Graded on the modified Davis scale — 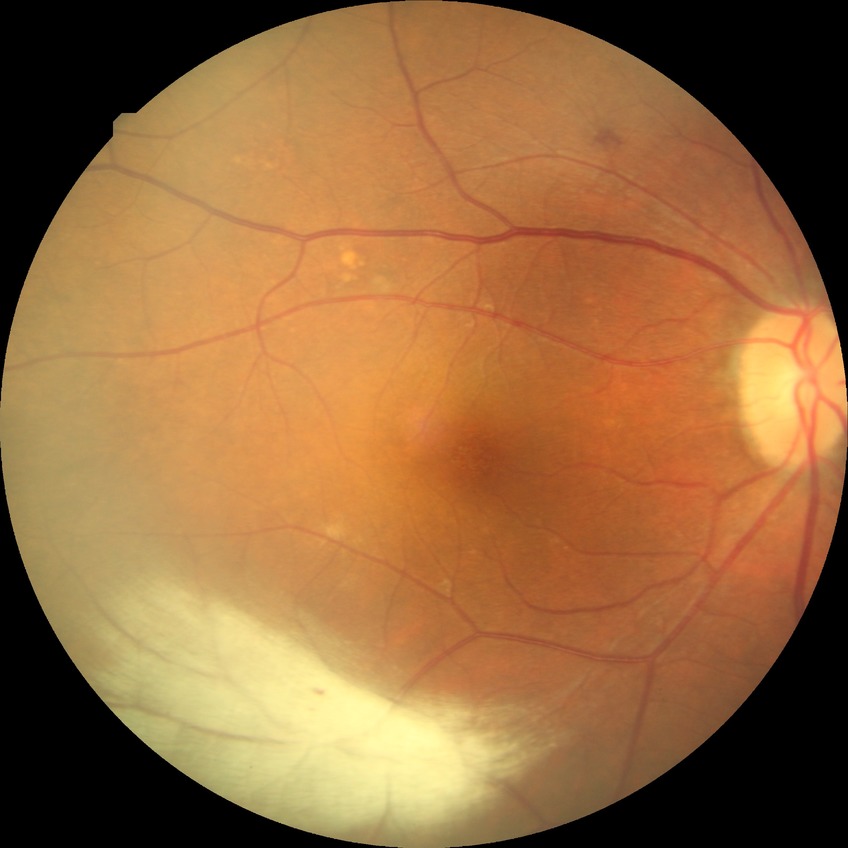
diabetic retinopathy (DR)=NDR (no diabetic retinopathy).